Davis DR grading · 848 by 848 pixels · no pharmacologic dilation:
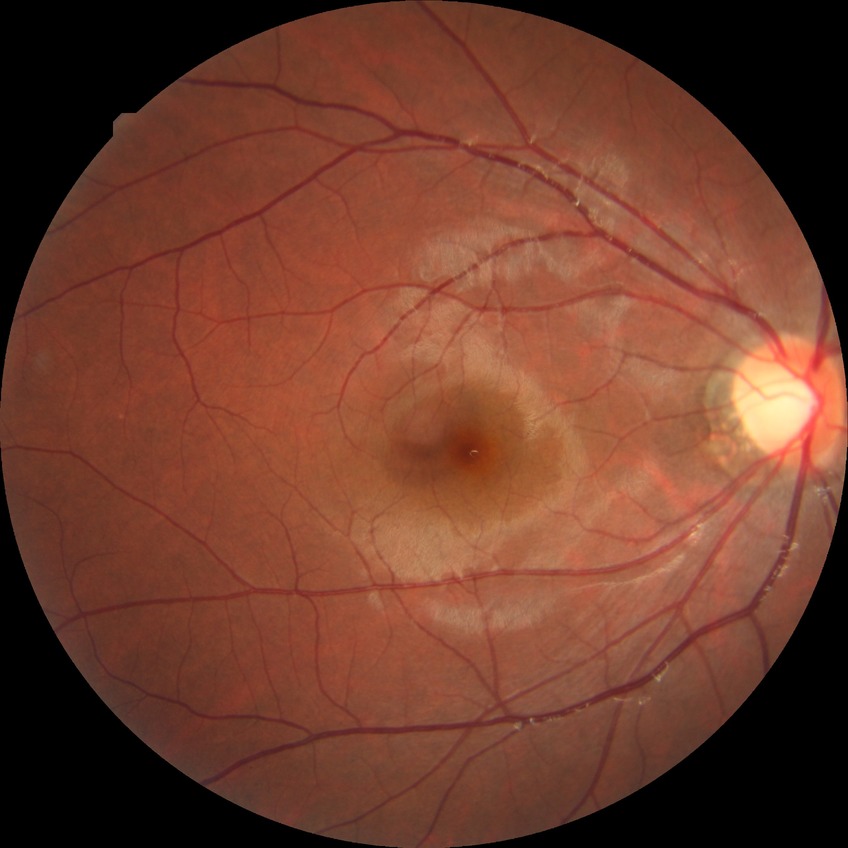

Modified Davis grading is no diabetic retinopathy.